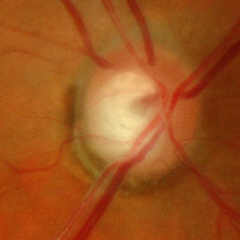

Glaucomatous optic neuropathy is present. Fundus appearance consistent with advanced glaucoma. (Criteria: near-total cupping of the optic nerve head, with or without severe visual field loss within the central 10 degrees of fixation.)